45° FOV, image size 2212x1659, retinal fundus photograph — 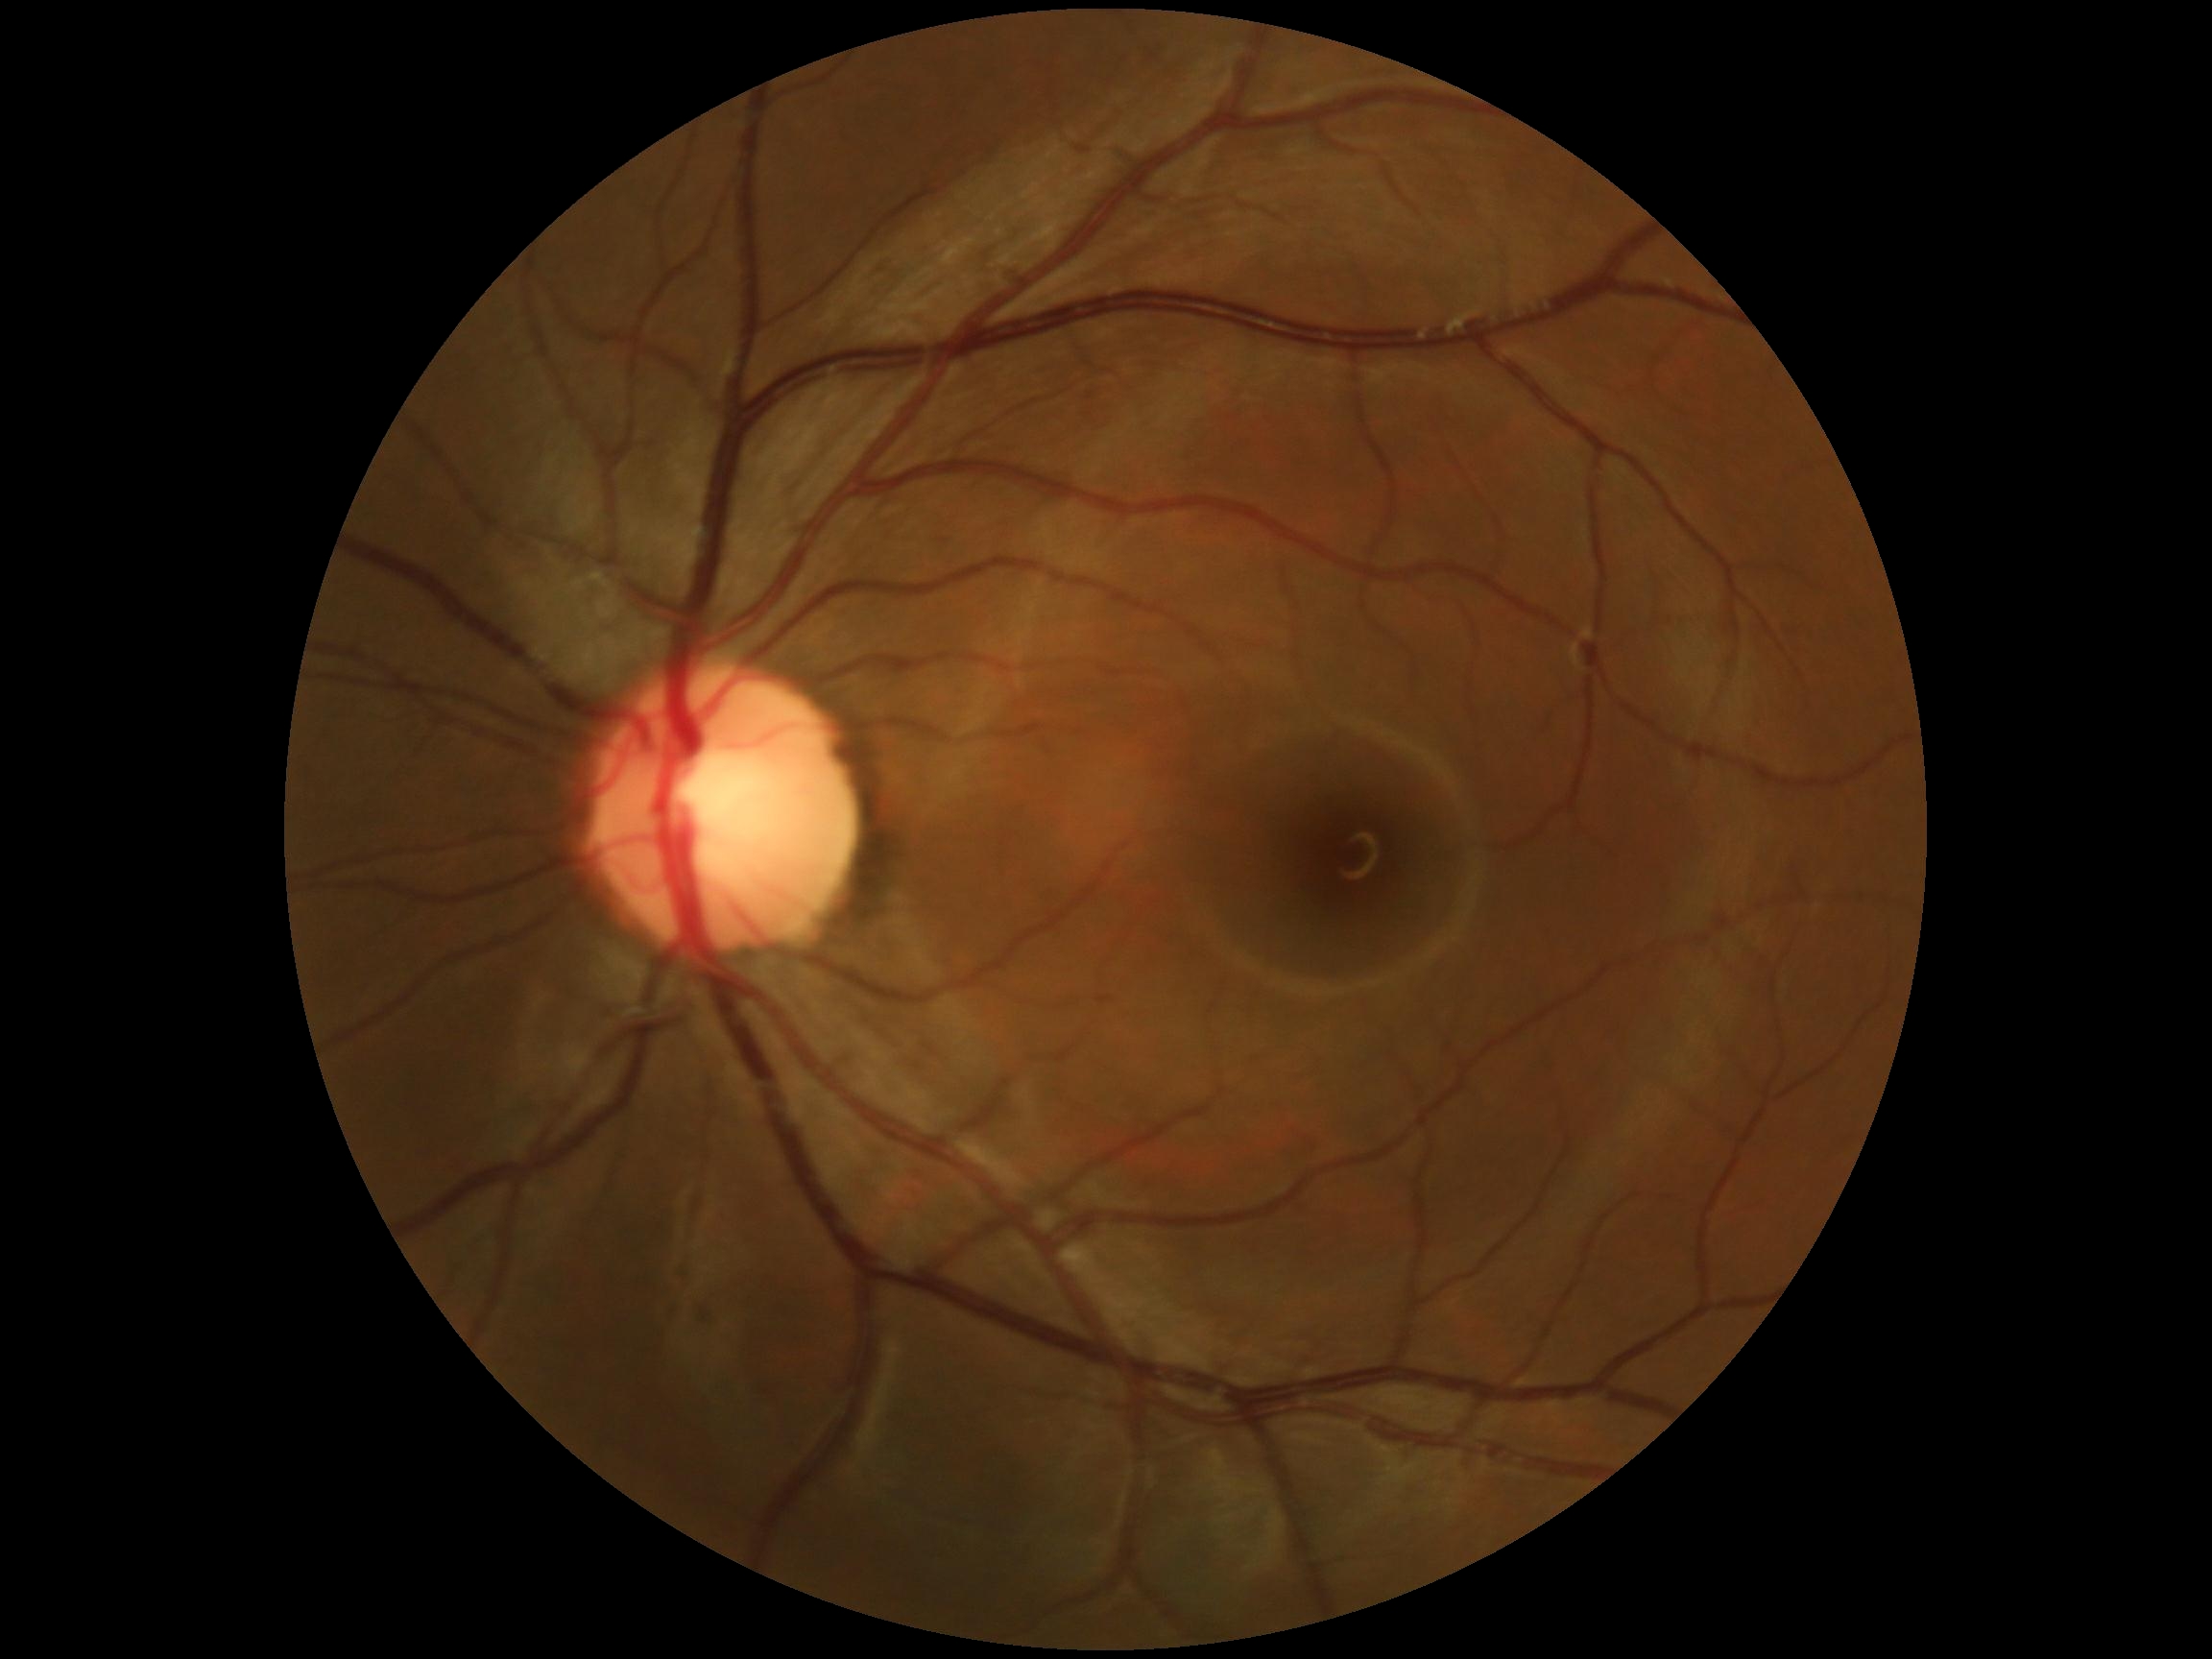 diabetic retinopathy grade: 0/4 — no visible signs of diabetic retinopathy.